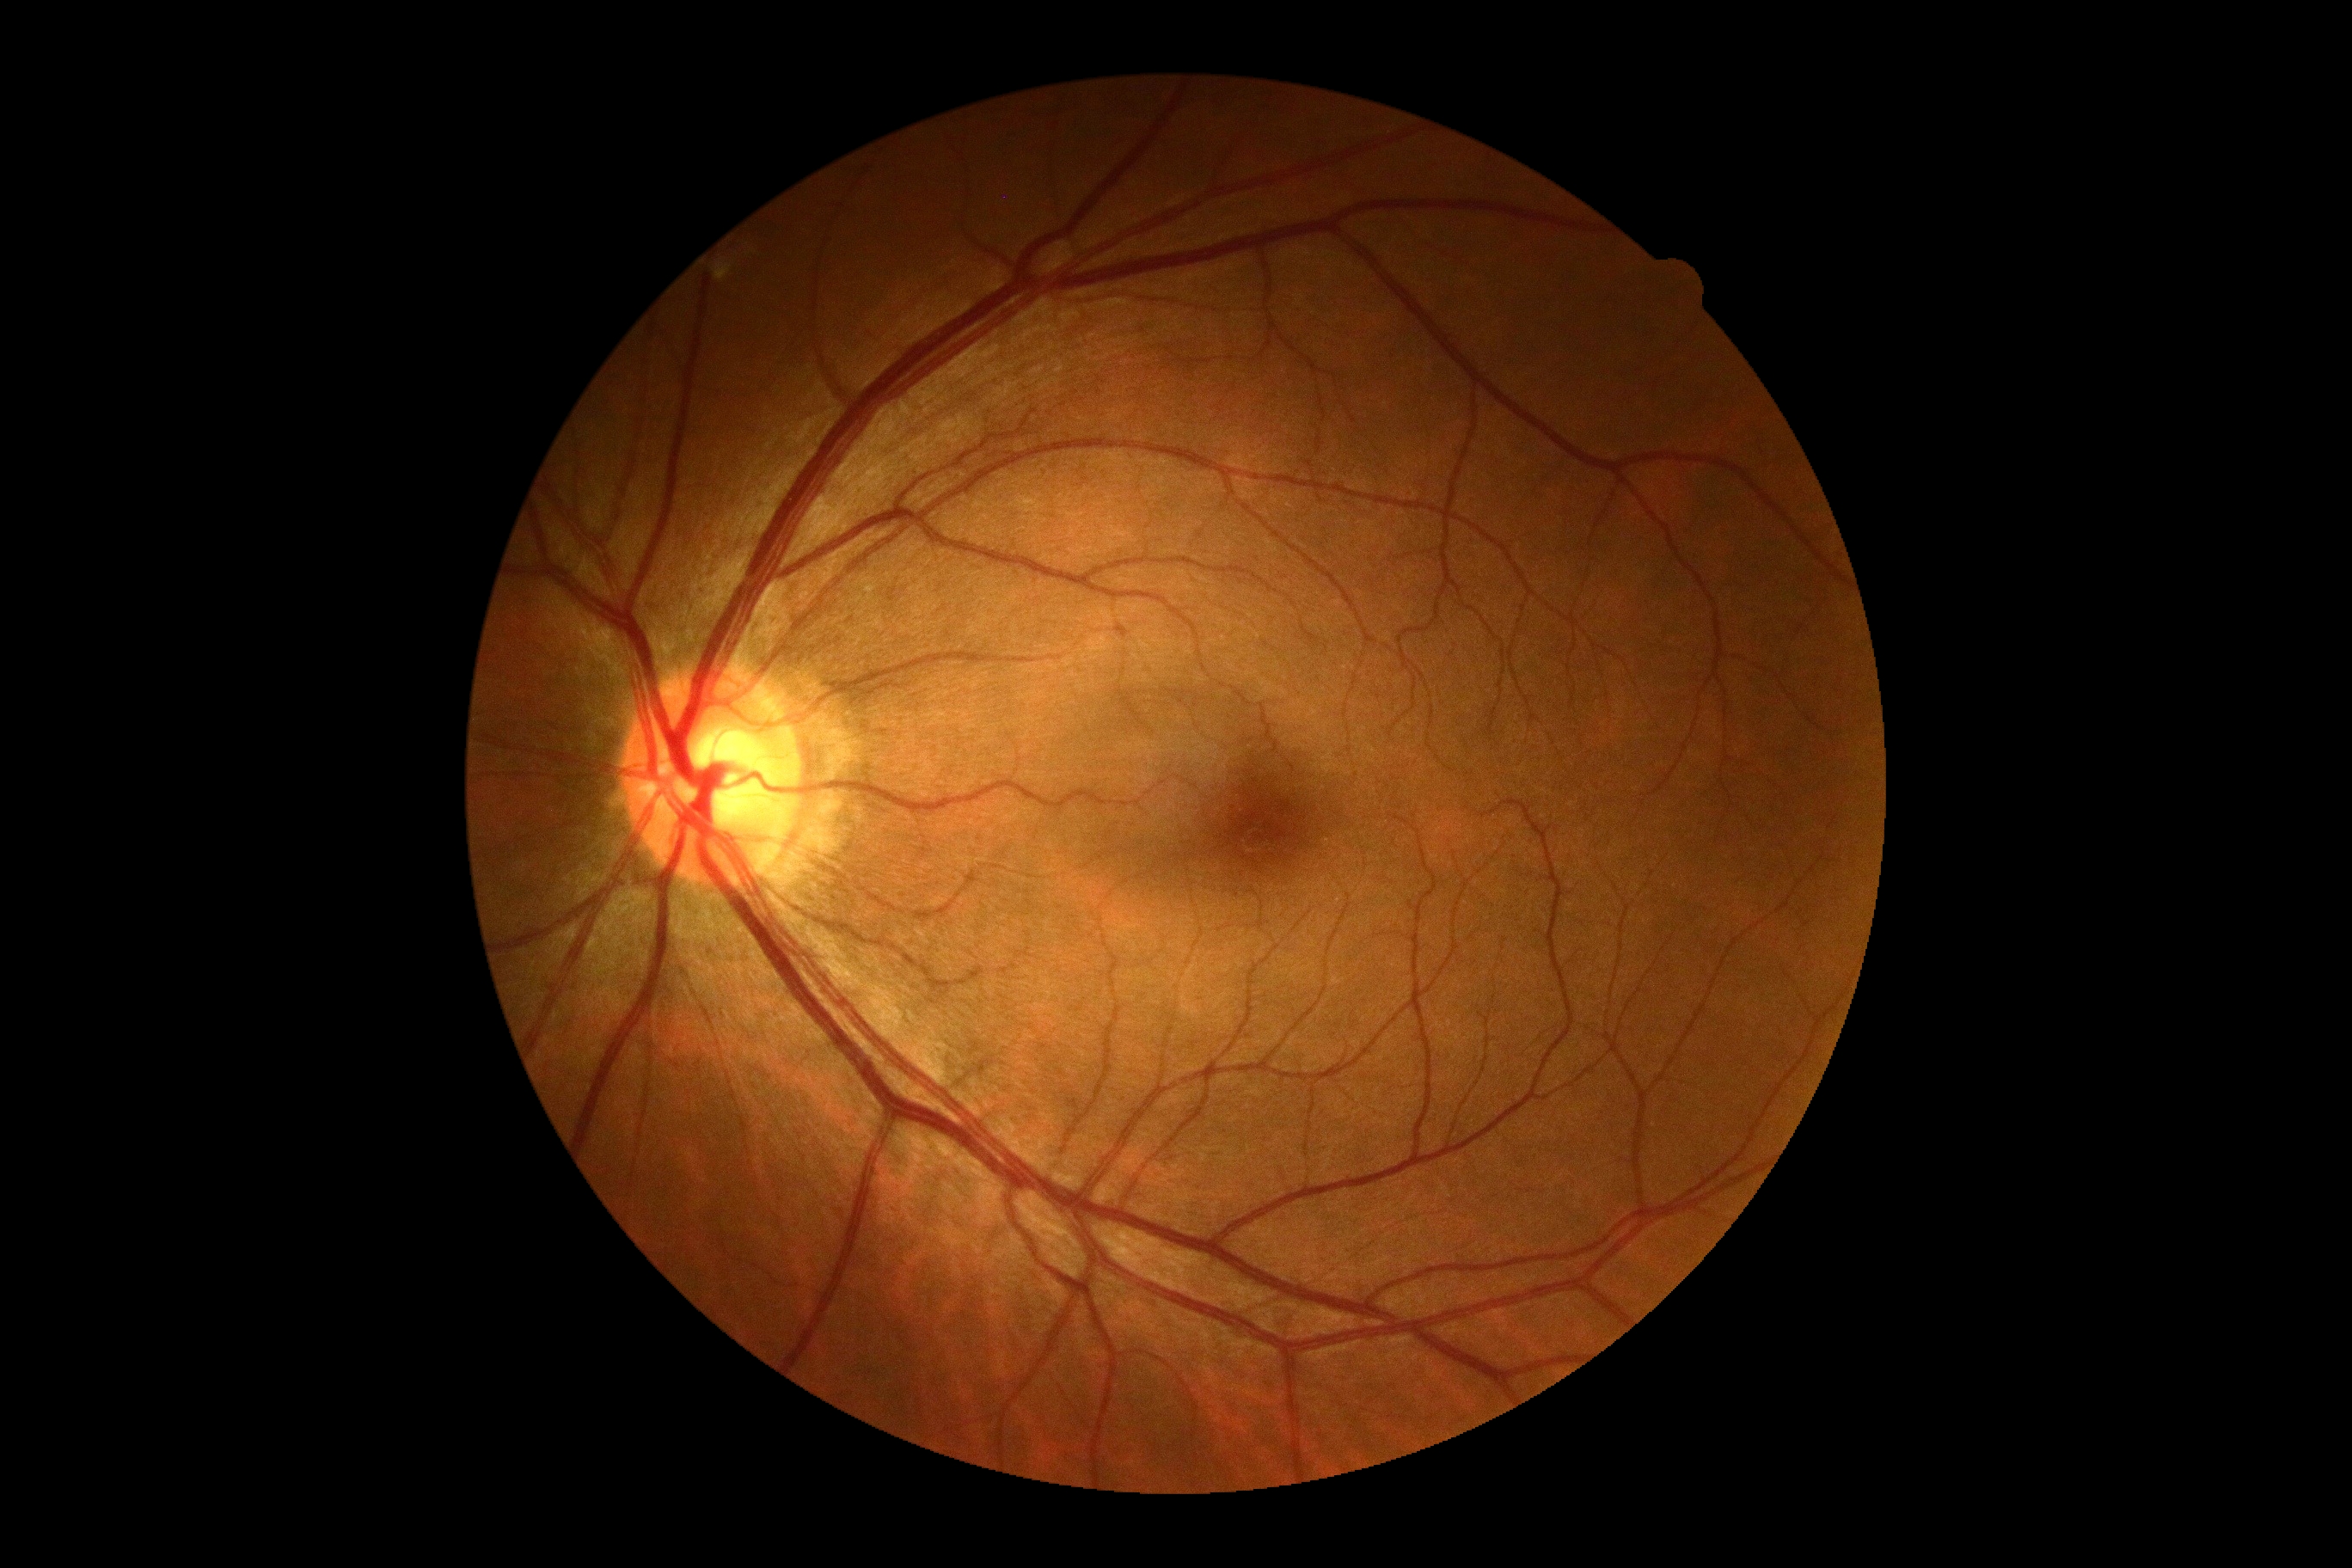 DR grade is 0 (no apparent retinopathy).
No DR findings.